45 degree fundus photograph
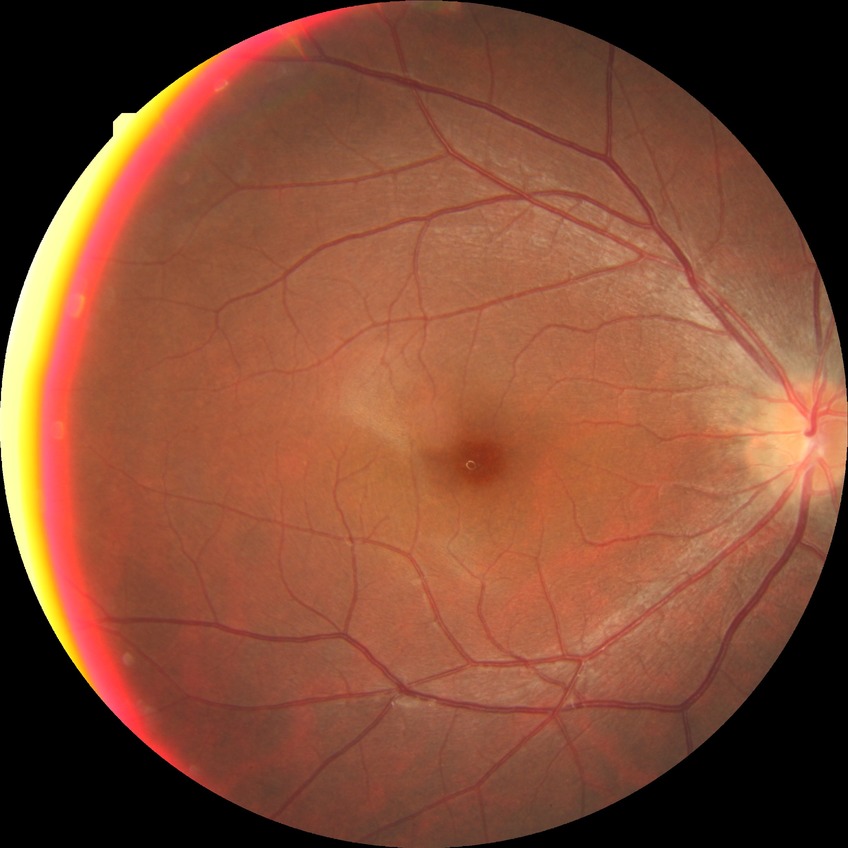 DR is NDR.